Posterior pole color fundus photograph · graded on the modified Davis scale:
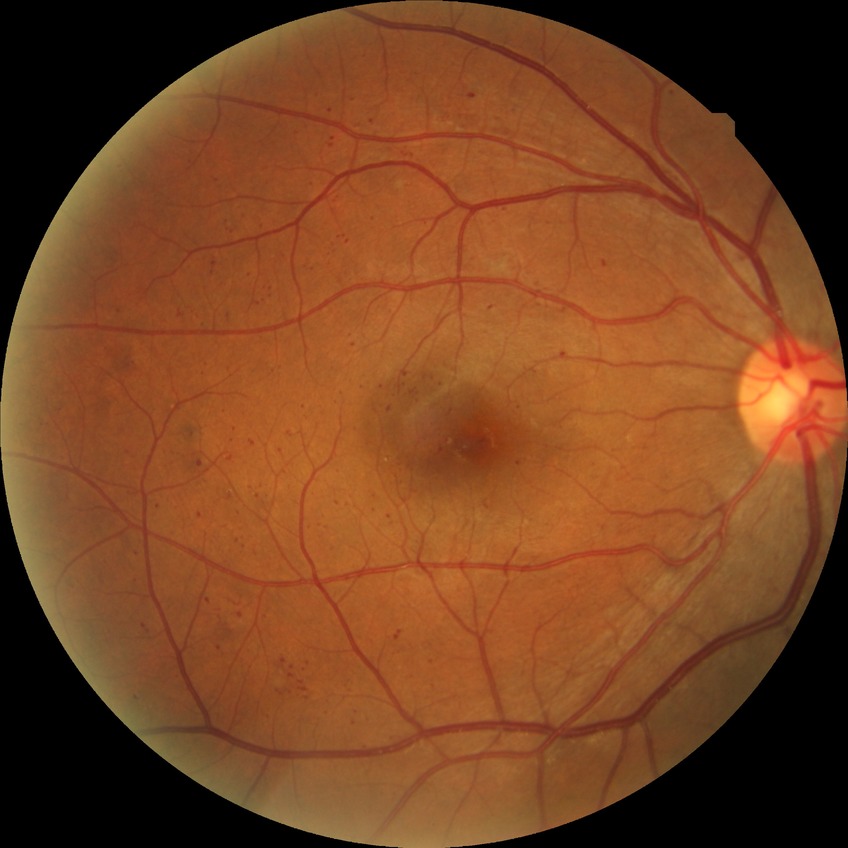 Findings:
– diabetic retinopathy (DR) — simple diabetic retinopathy (SDR)